45° field of view; 848 by 848 pixels:
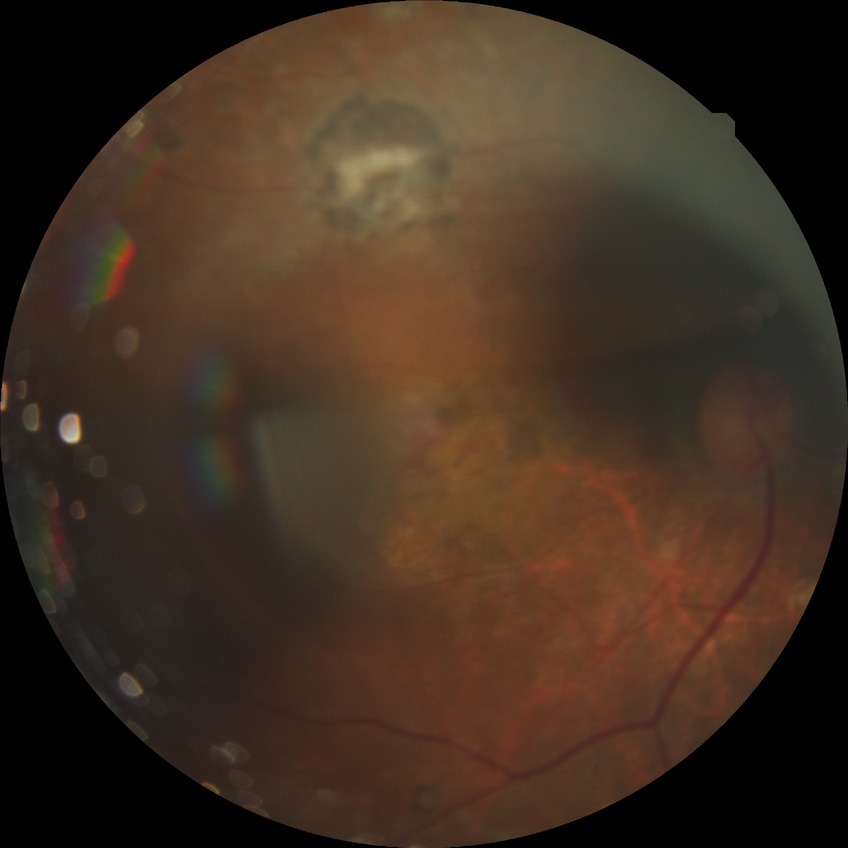

davis_grade: PDR (proliferative diabetic retinopathy)